Without pupil dilation, 45° FOV, camera: NIDEK AFC-230, 848 x 848 pixels — 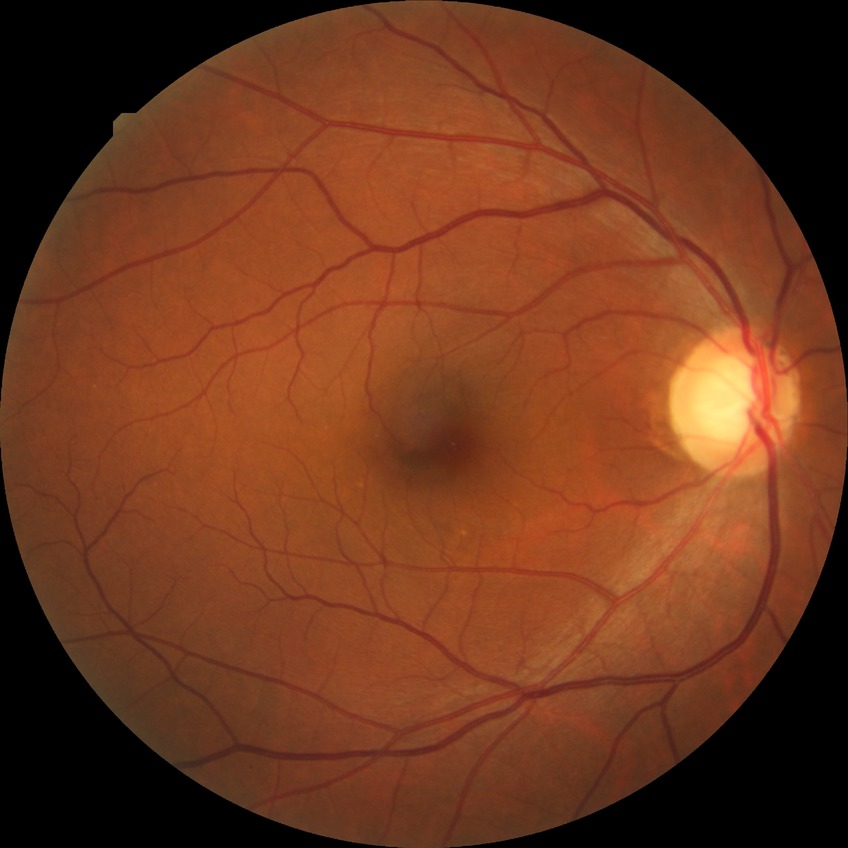 Davis grading: no diabetic retinopathy.